Wide-field fundus photograph of an infant:
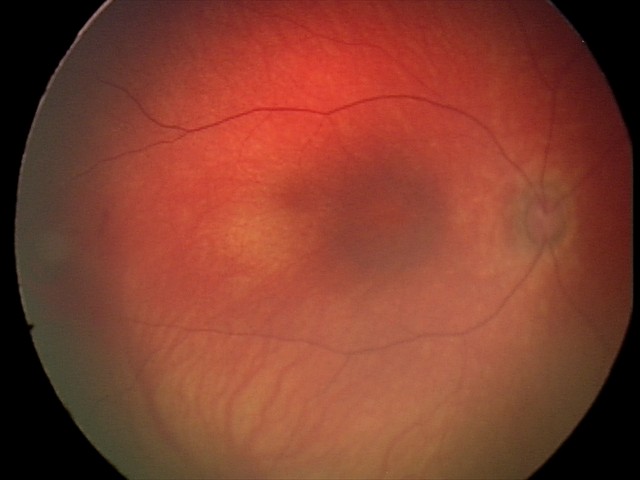
Screening: retinal hemorrhages.